Fundus photo — 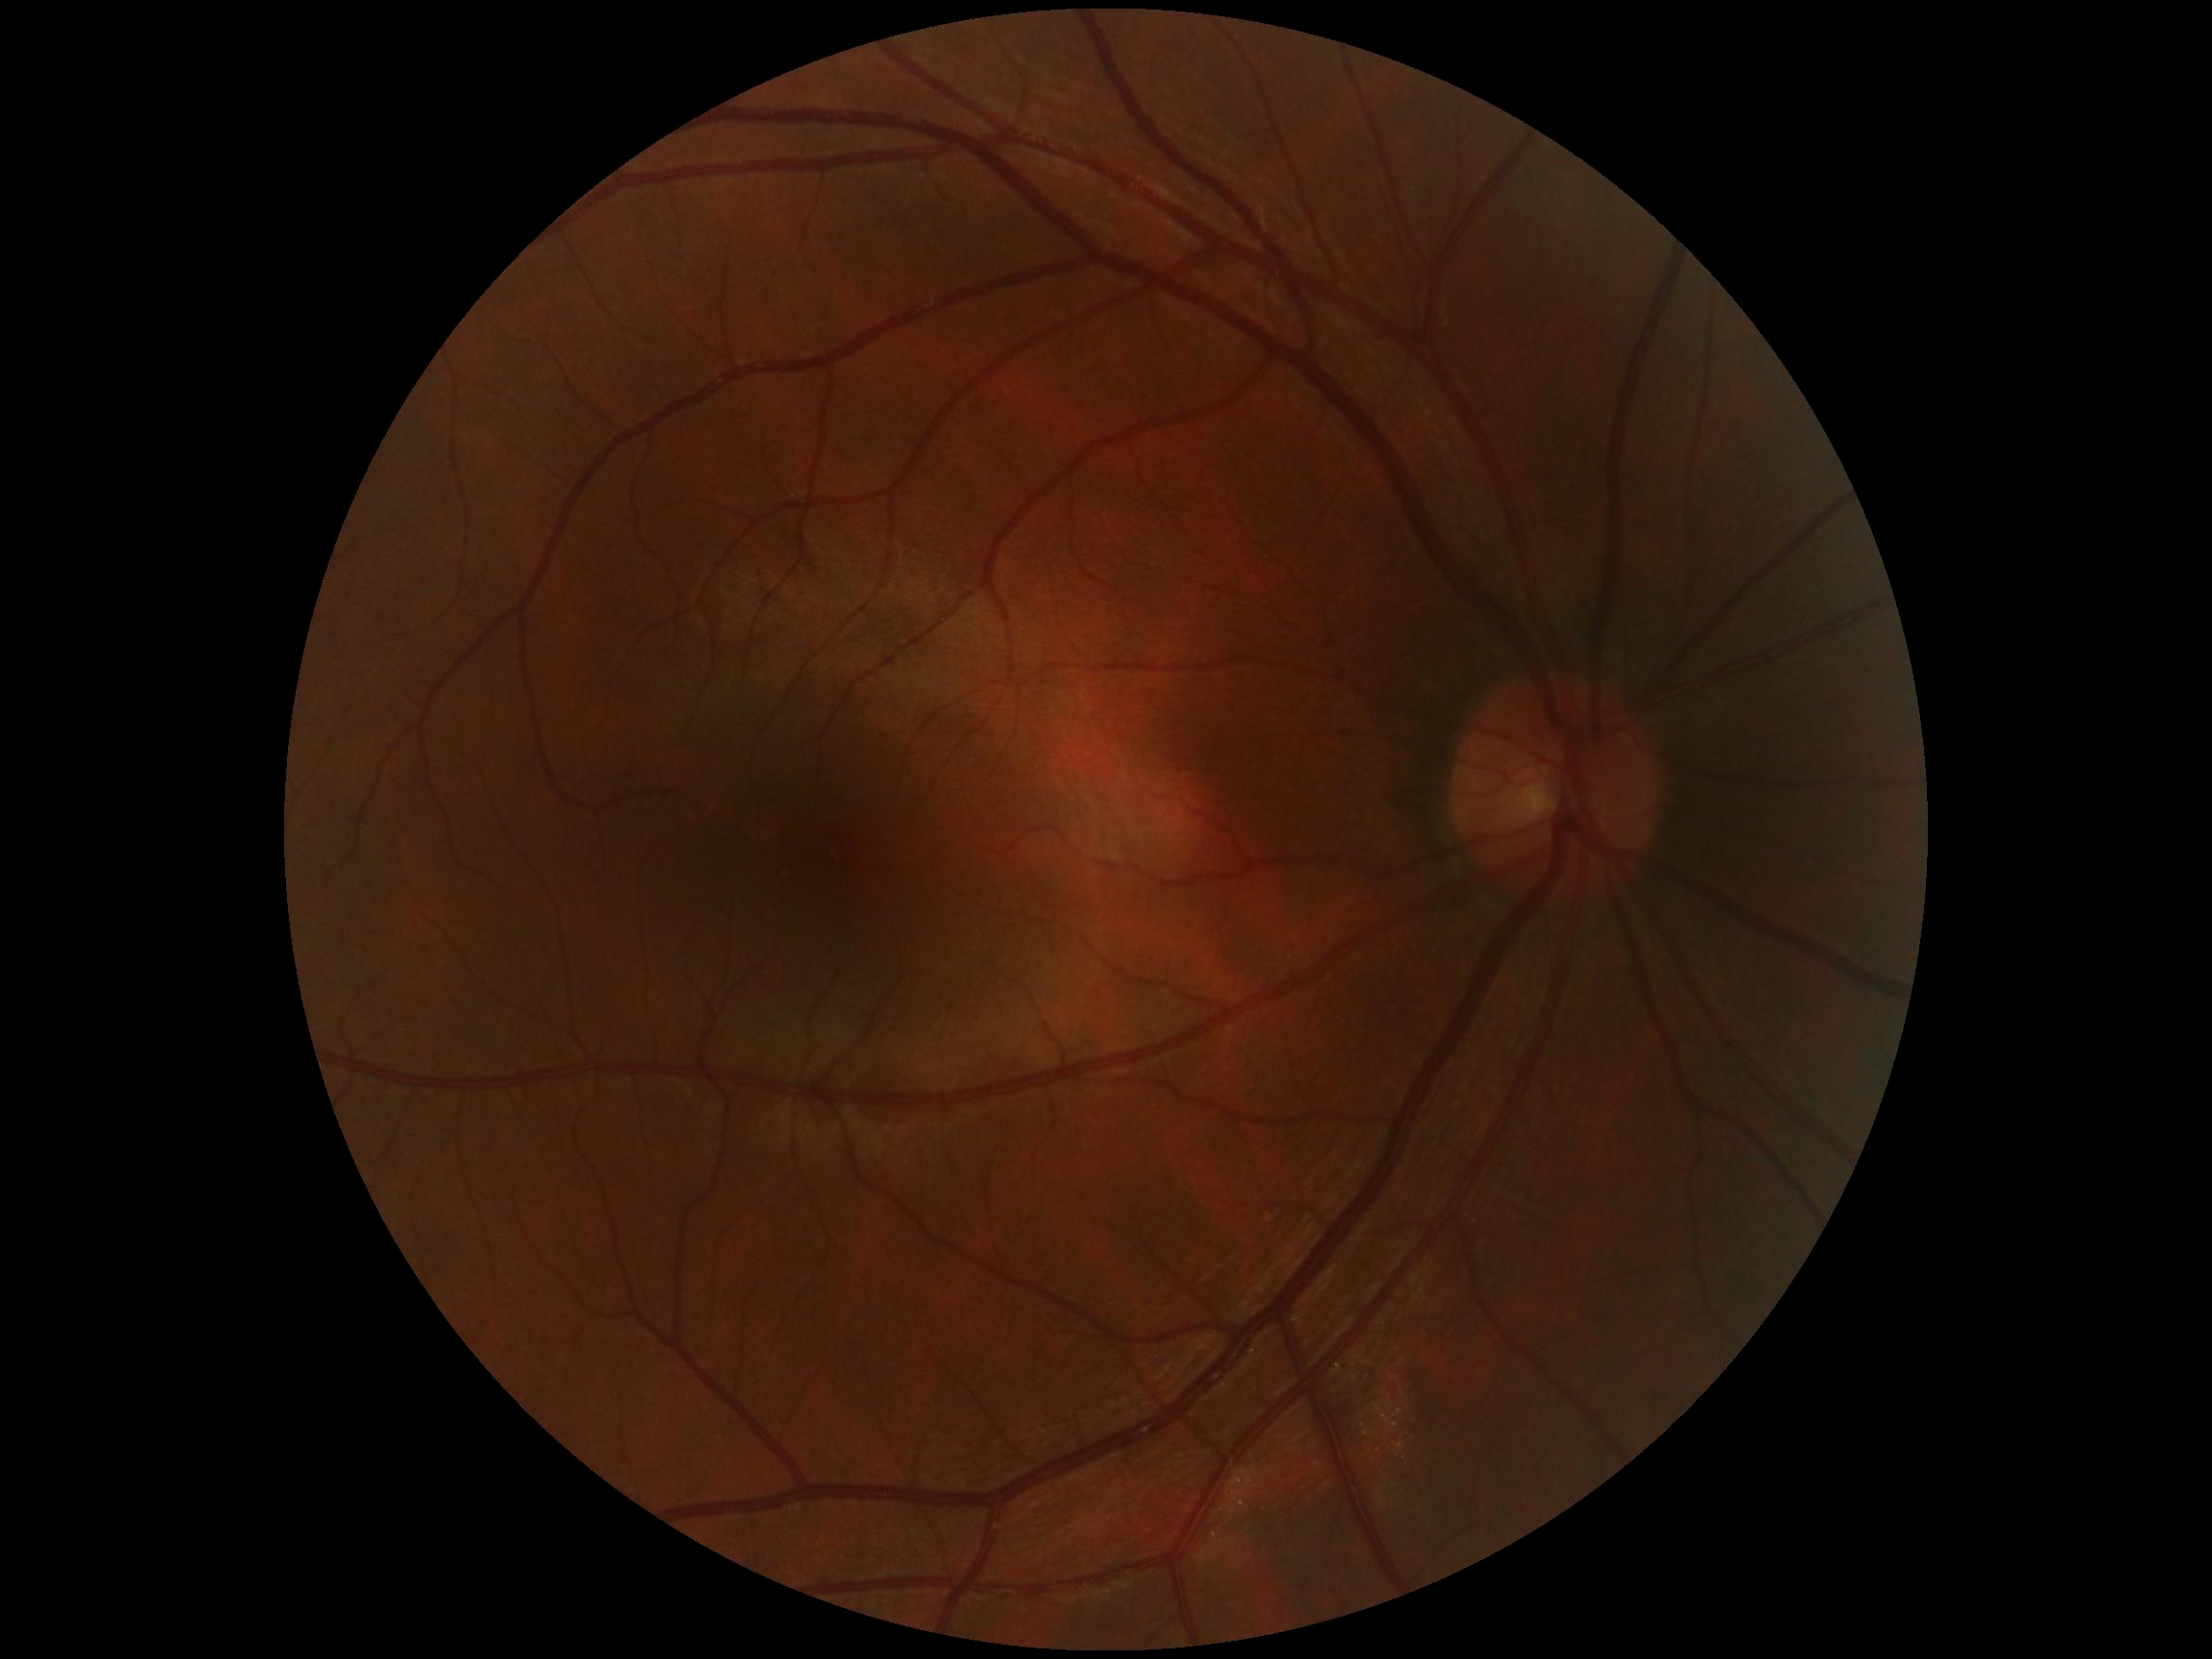 No signs of diabetic retinopathy.
Retinopathy grade is 0.